Nonmydriatic fundus photograph, modified Davis classification, 848x848, FOV: 45 degrees, NIDEK AFC-230: 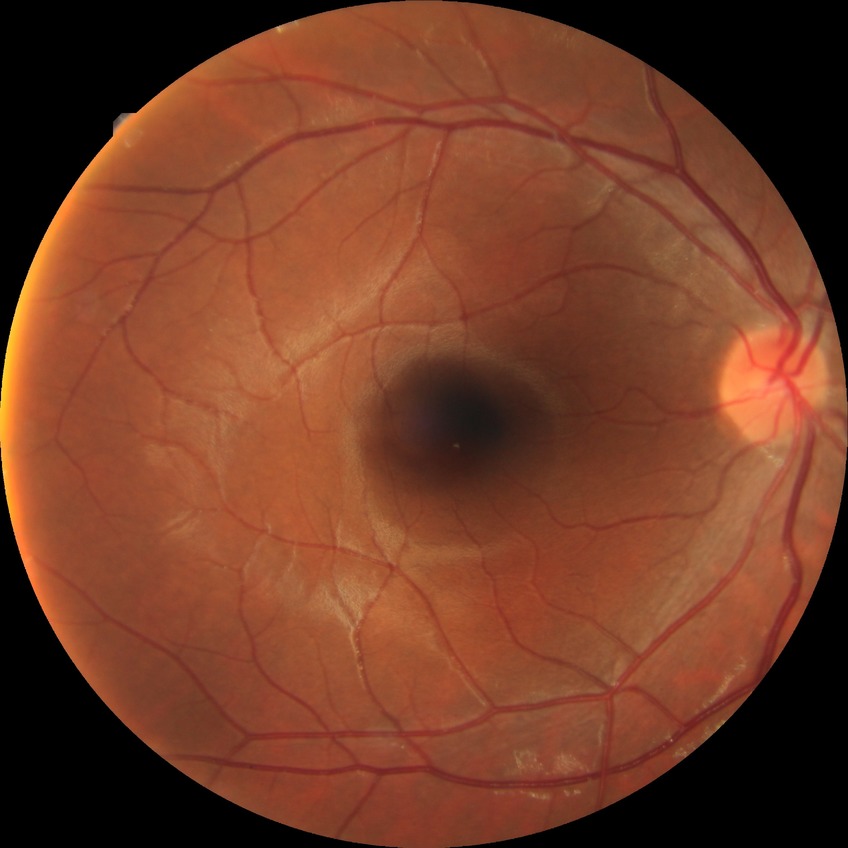 Diabetic retinopathy (DR): no diabetic retinopathy (NDR).